Without pupil dilation. Image size 848x848. Posterior pole photograph. 45° FOV: 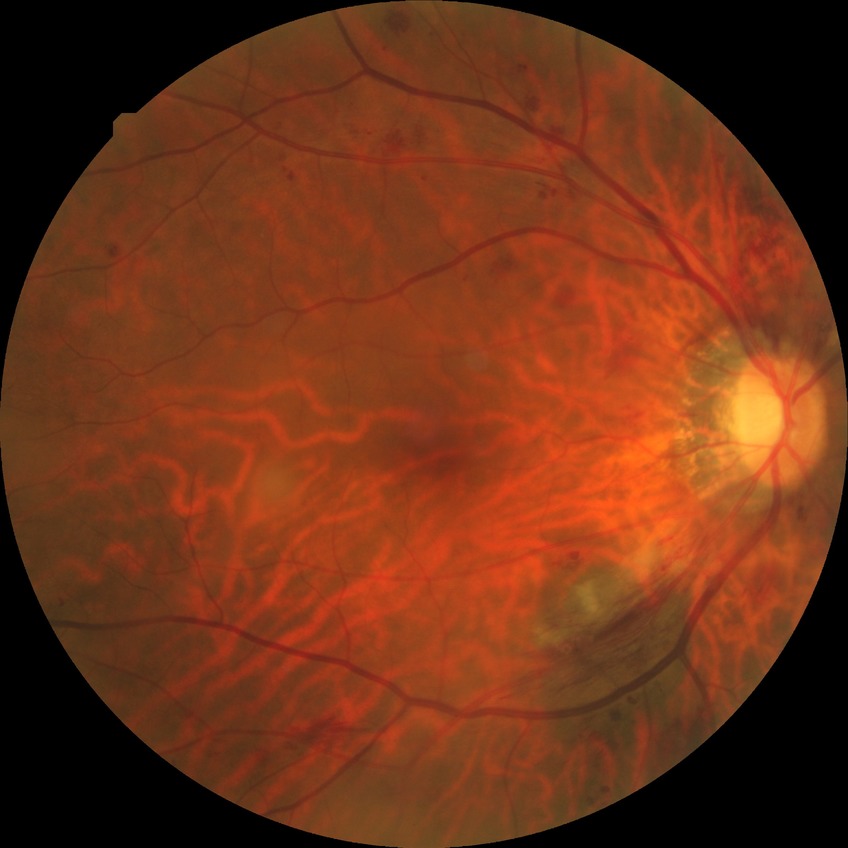
Diabetic retinopathy (DR) is pre-proliferative diabetic retinopathy (PPDR).